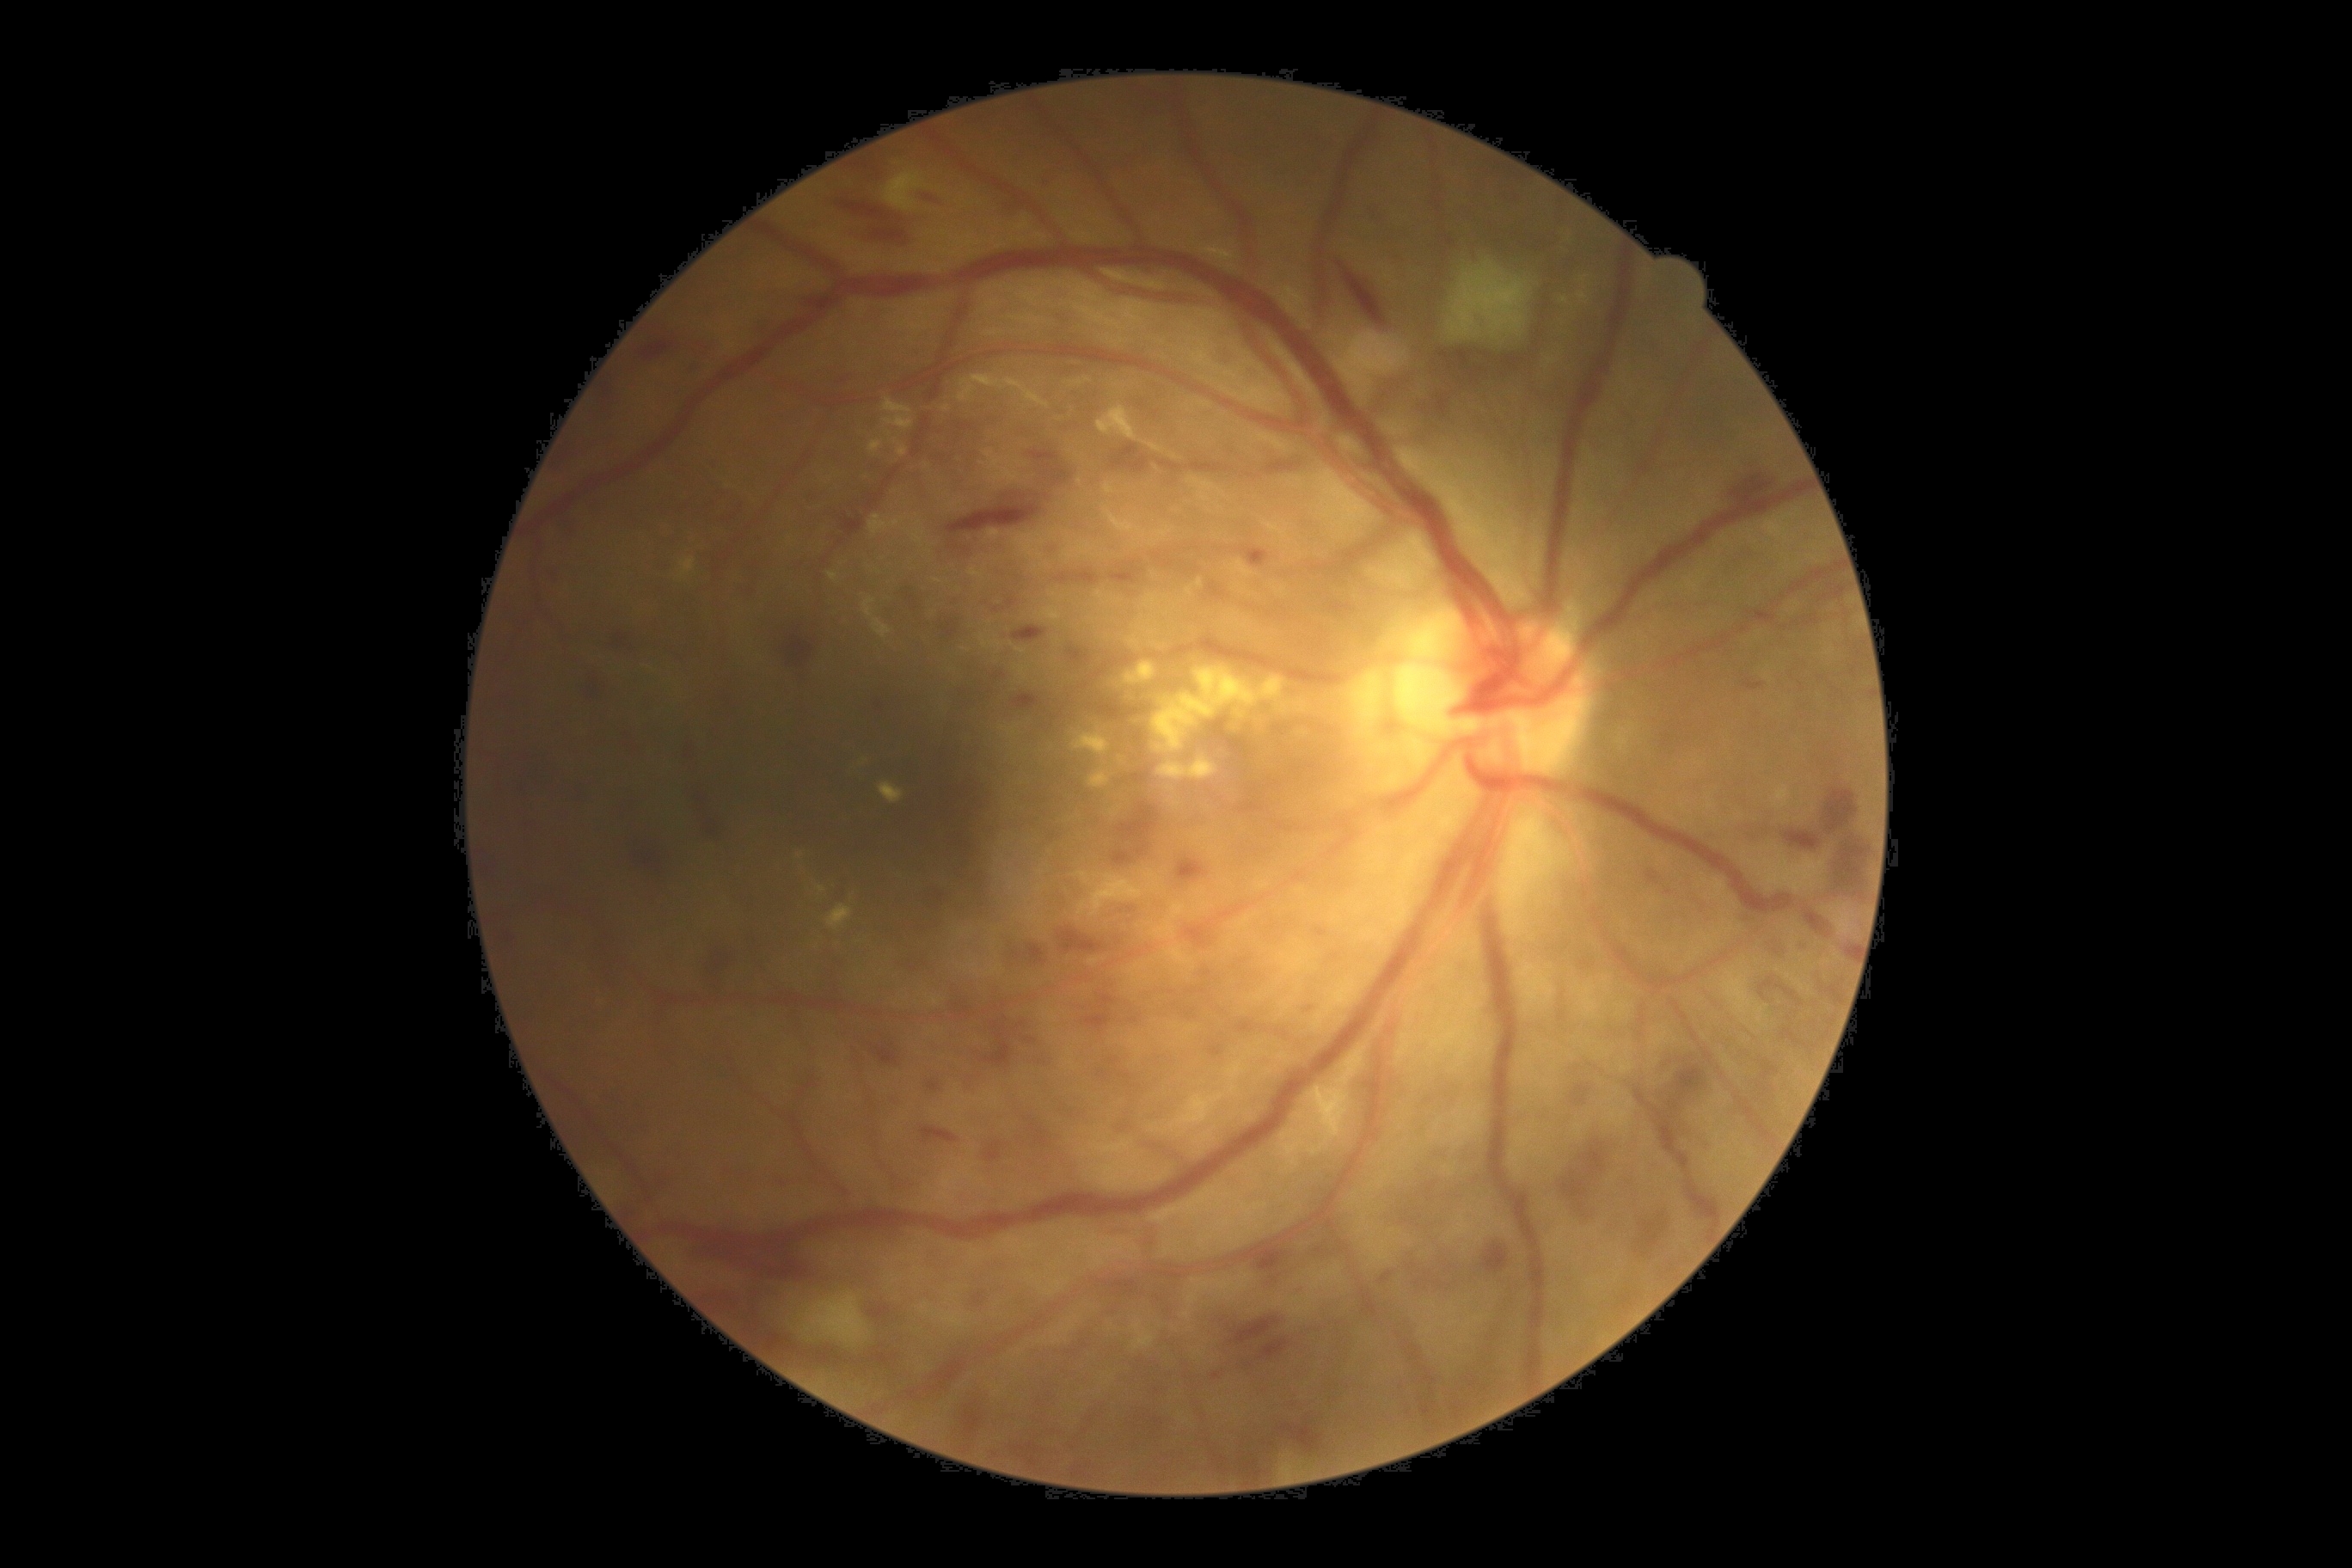 Retinopathy grade: 3 (severe NPDR).